Dilated-pupil acquisition. Posterior pole view. 50° field of view:
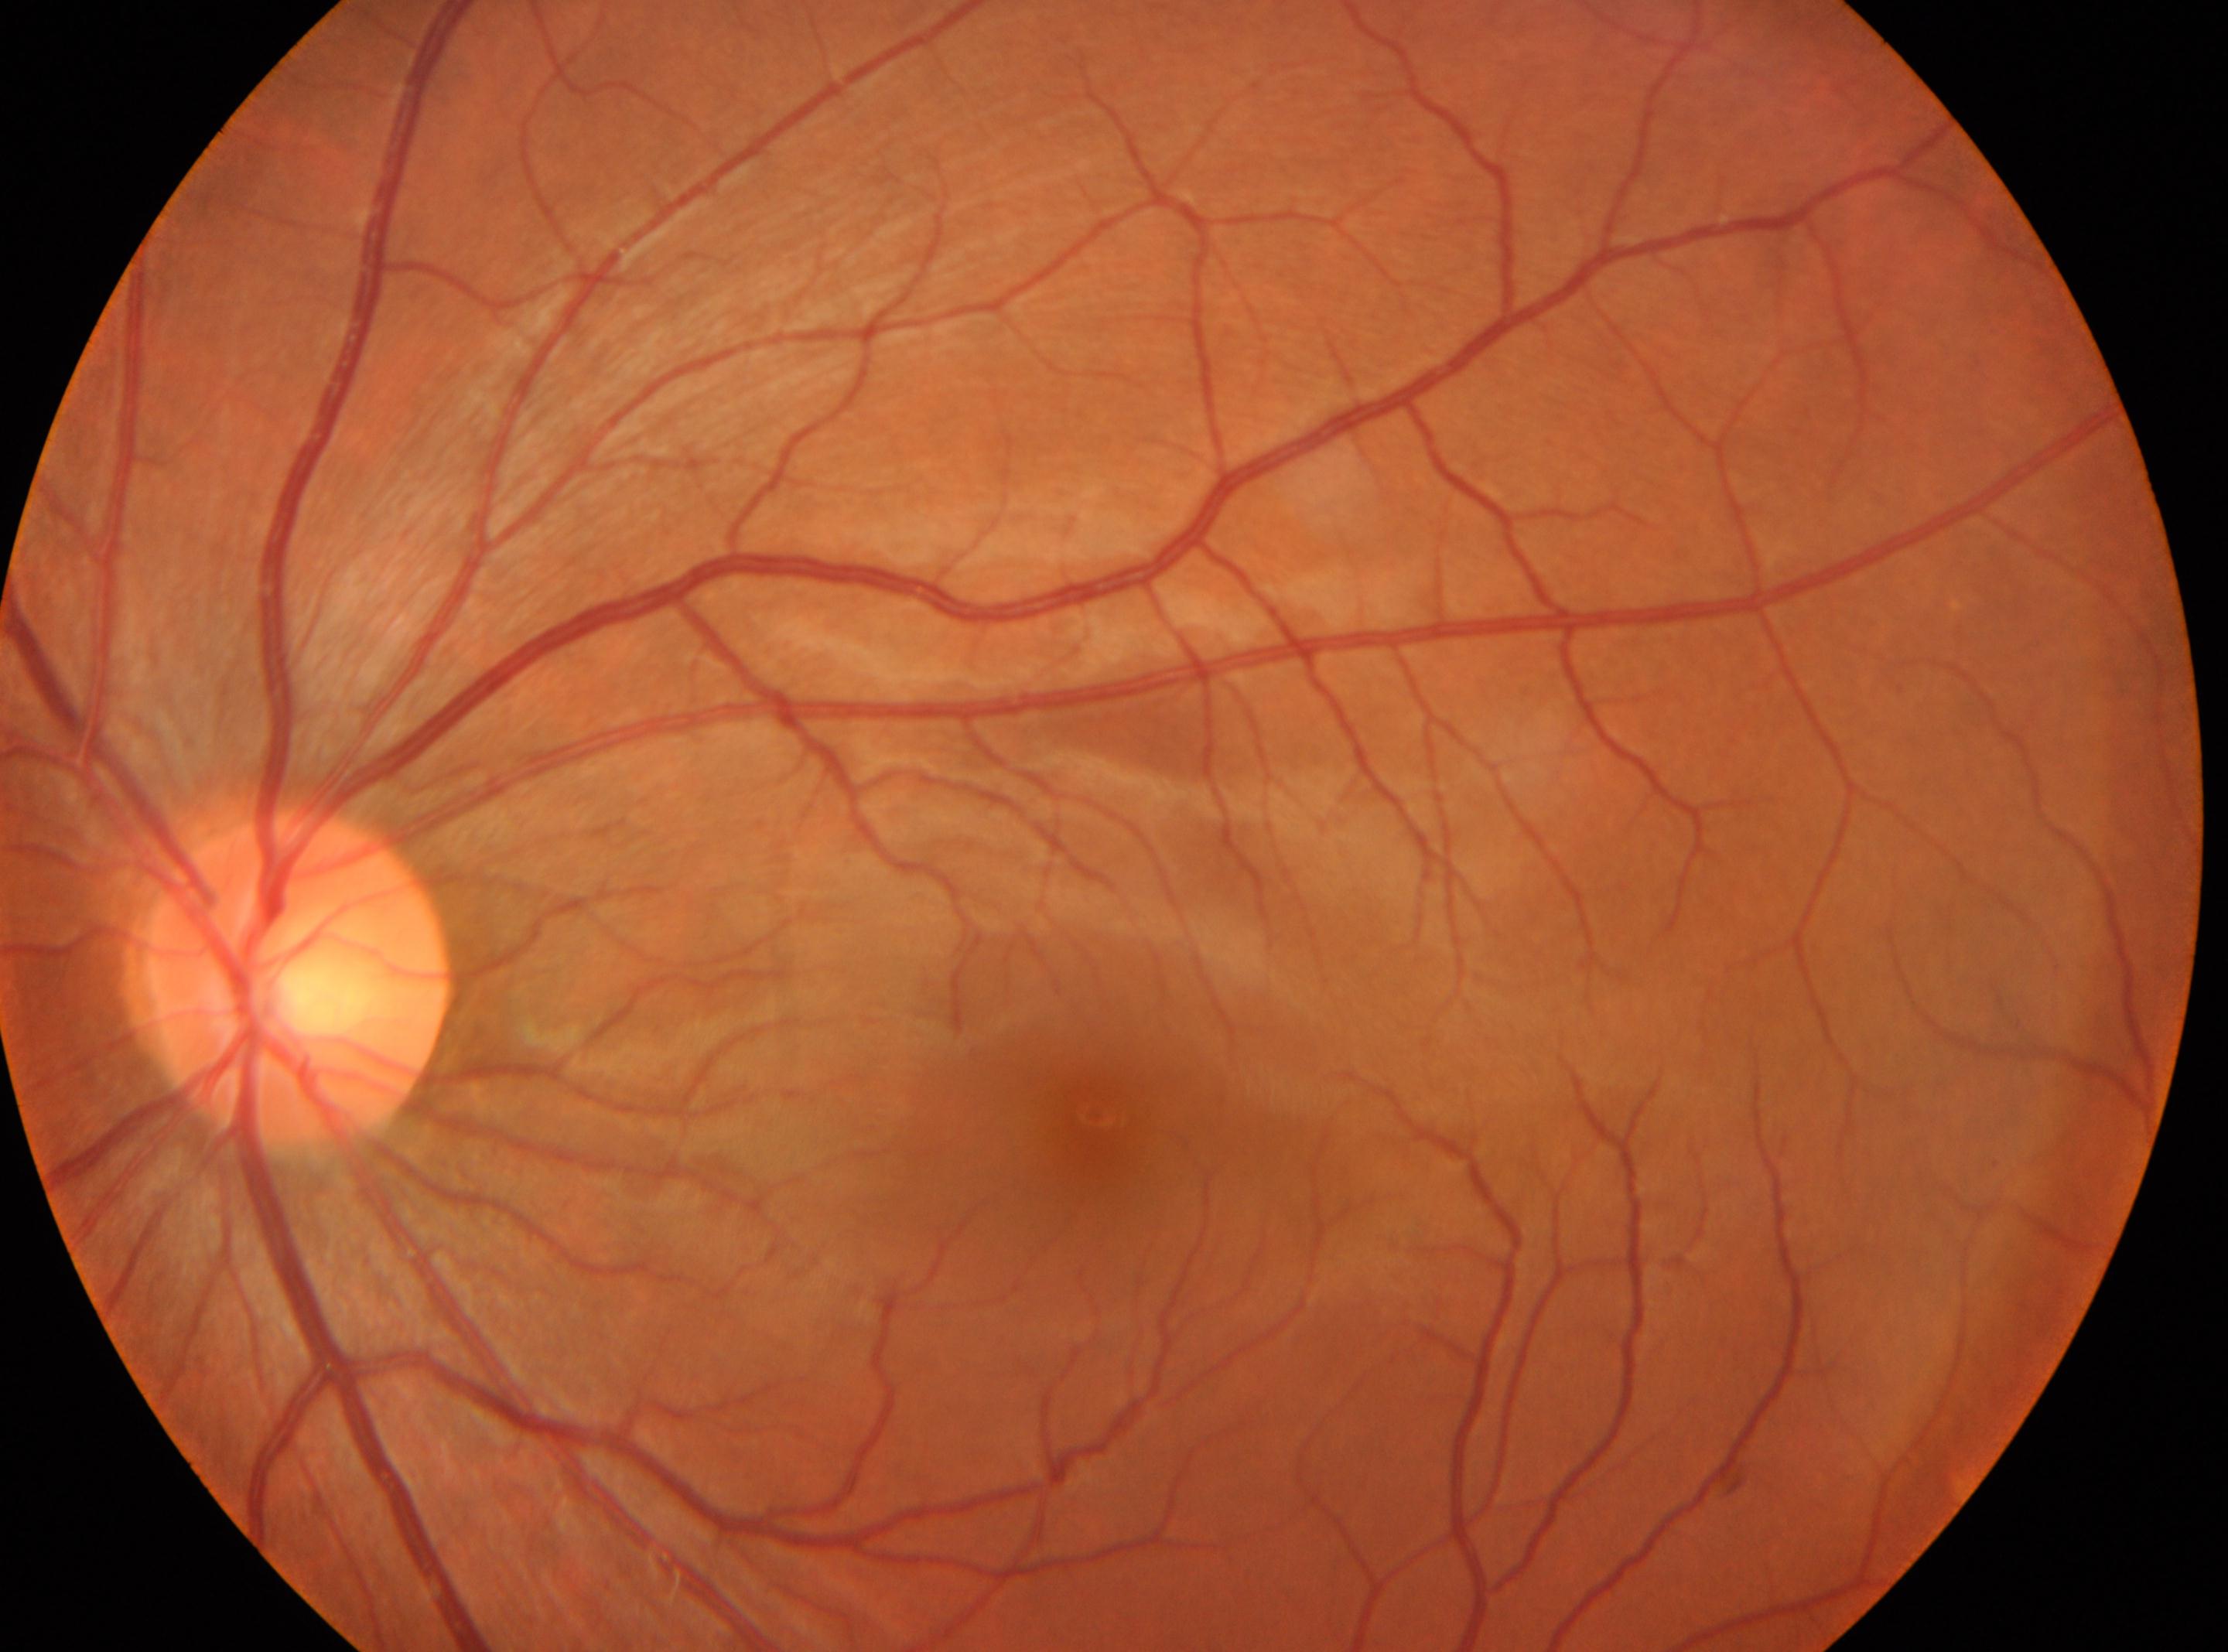
| feature | annotation |
|---|---|
| laterality | the left eye |
| diabetic retinopathy grade | no apparent retinopathy (0) |
| macula center | (x=1094, y=1112) |
| disc center | (x=295, y=981) |